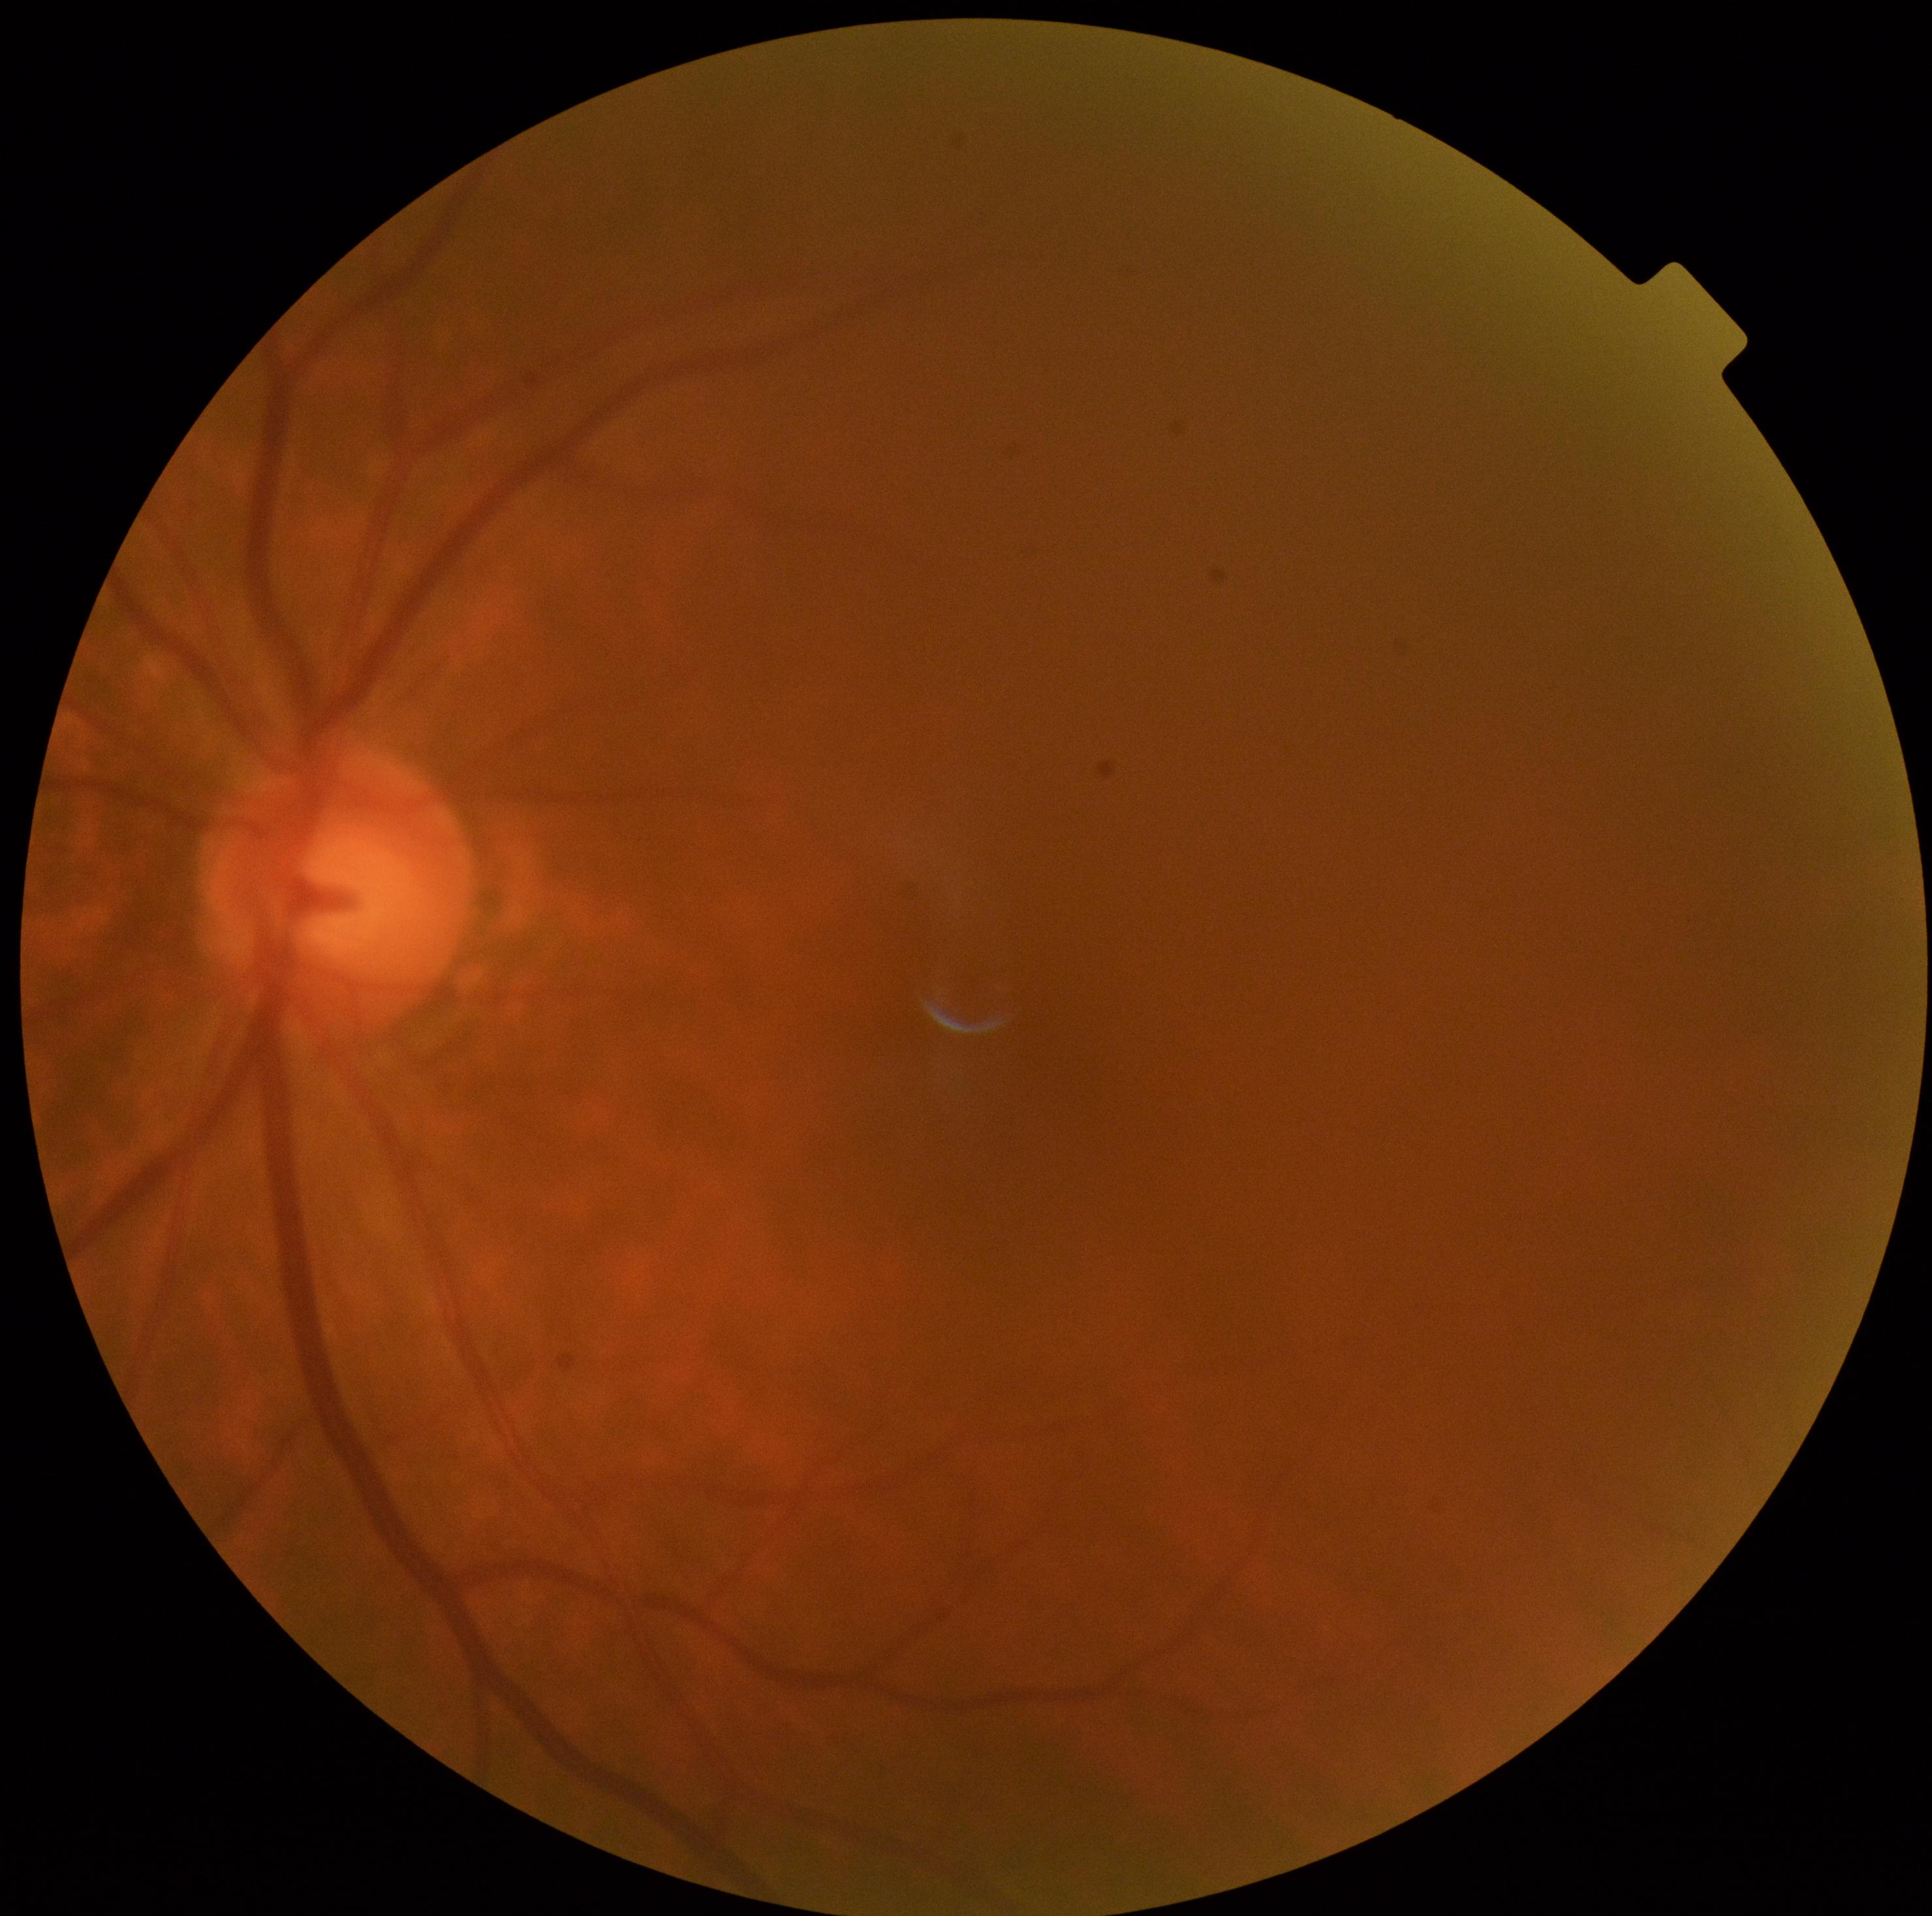   dr_grade: 0